Color fundus image. Captured on a Remidio FOP fundus camera: 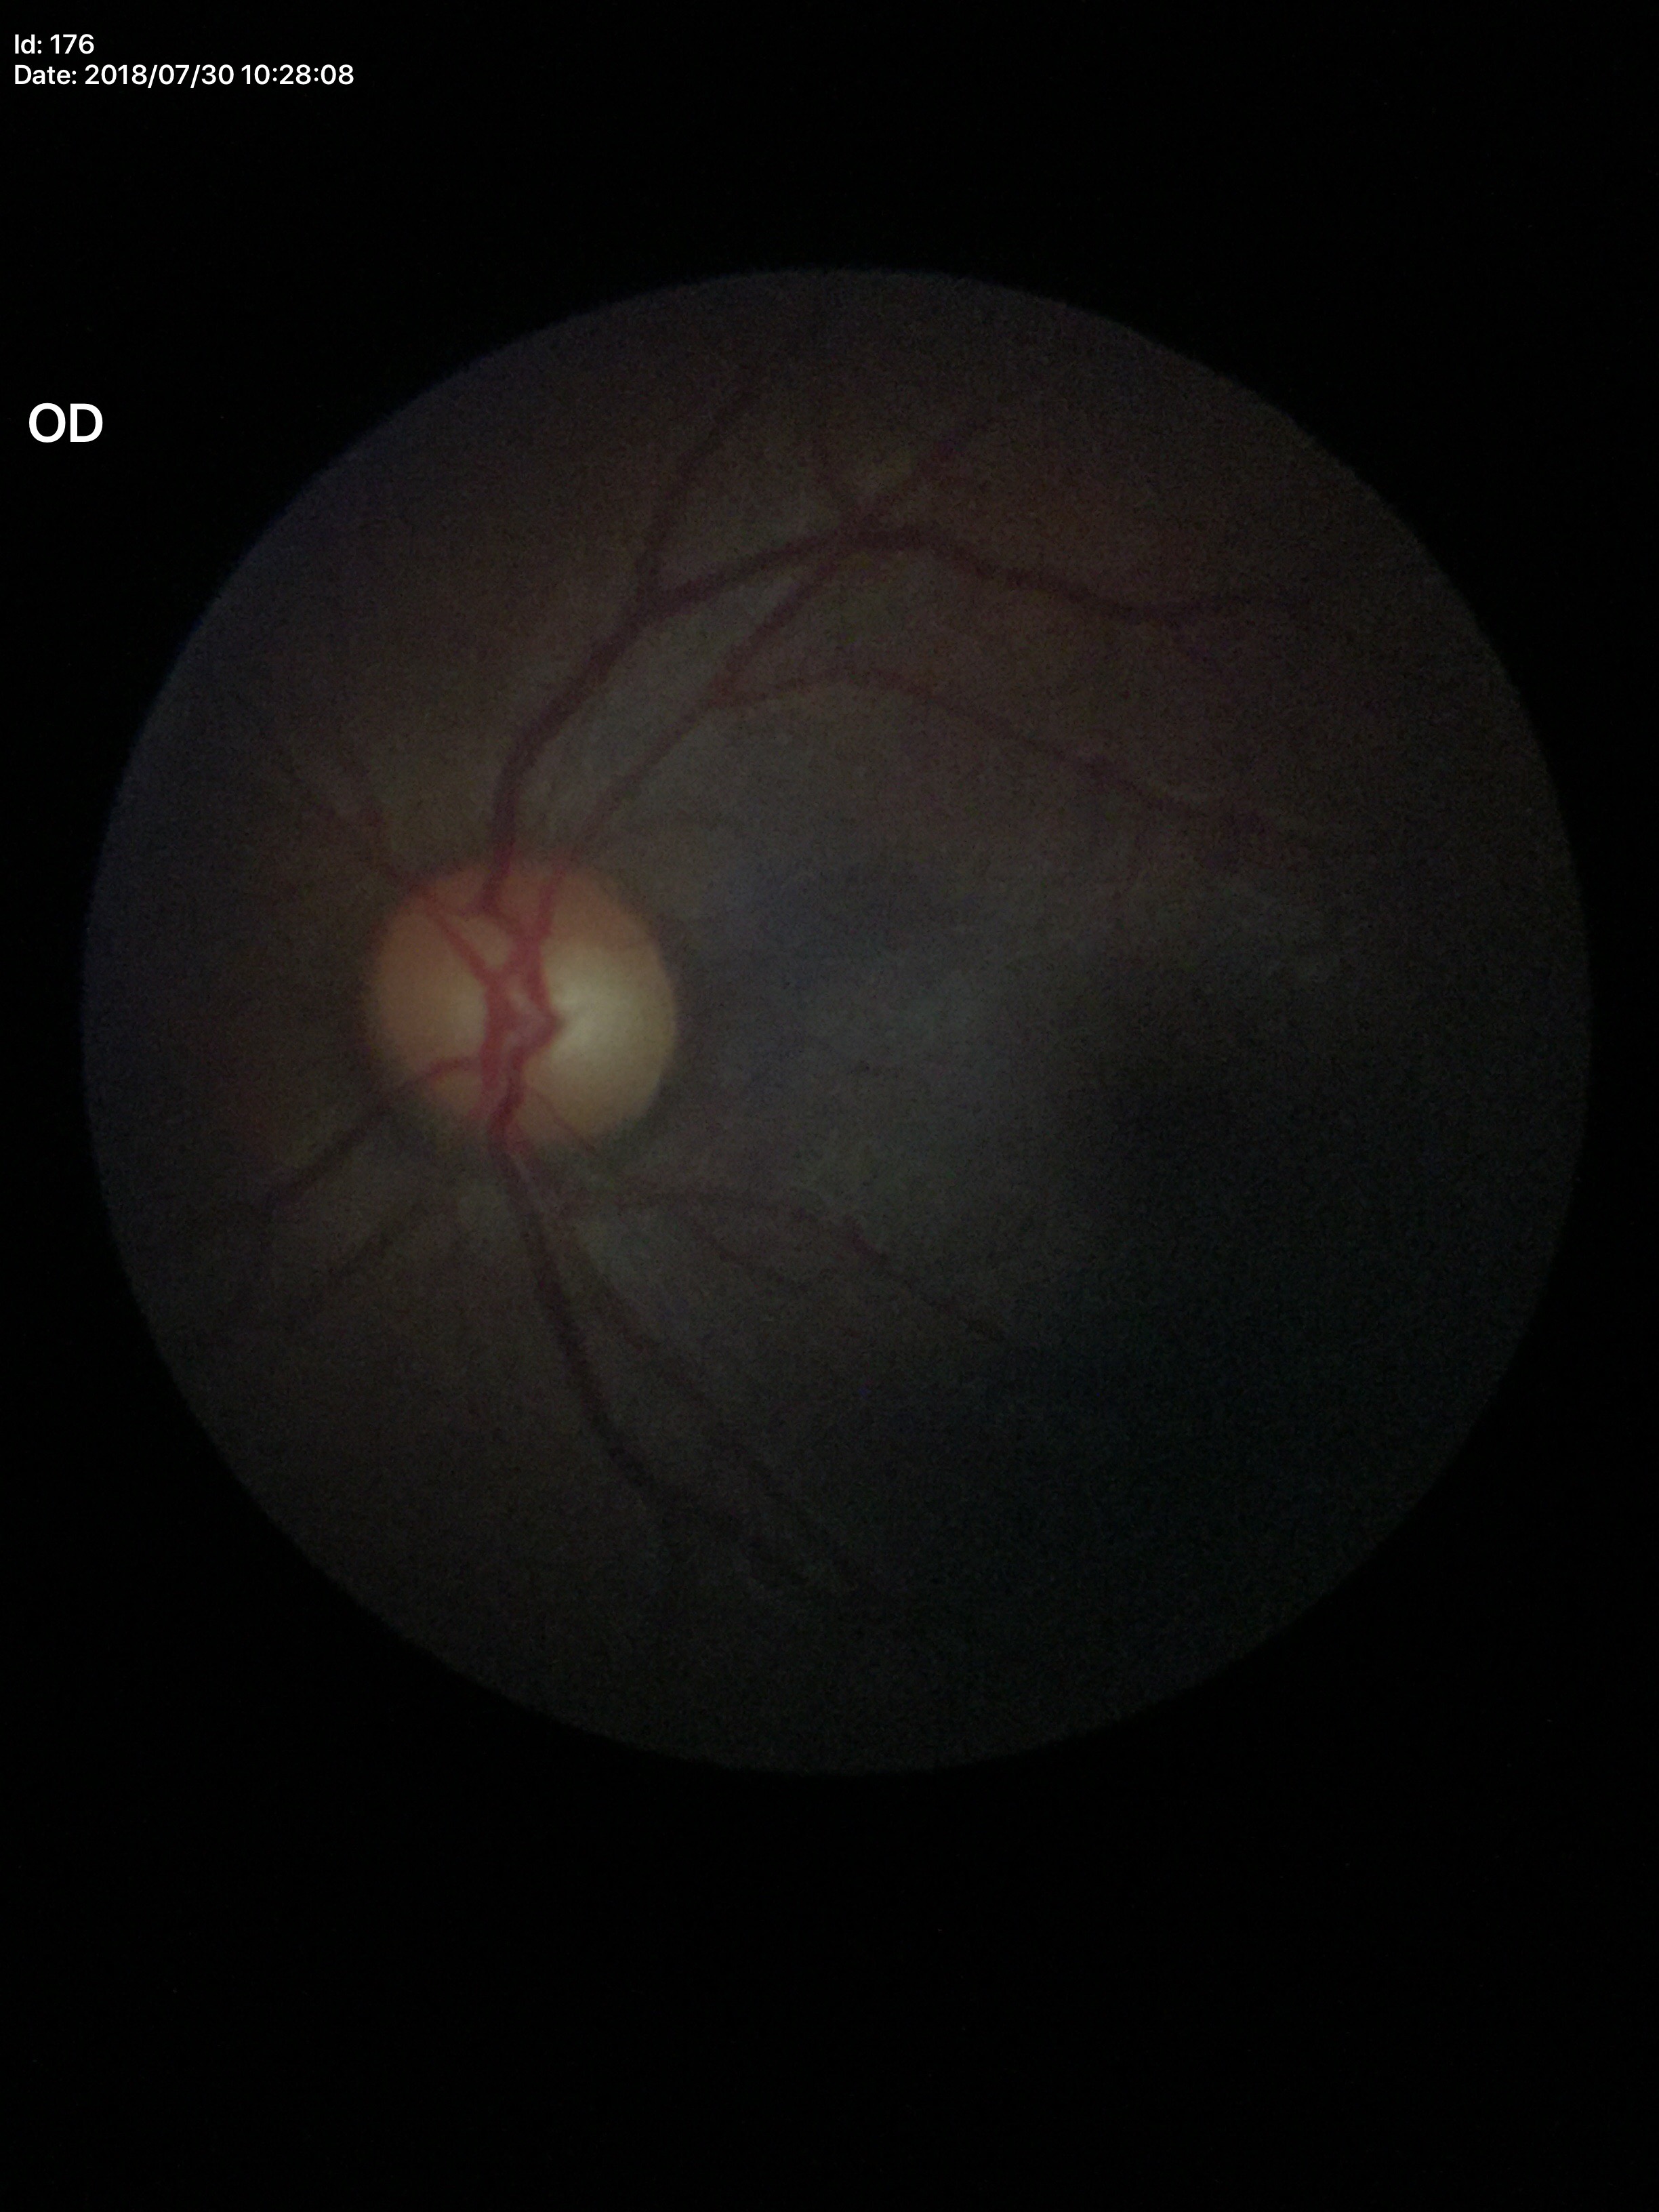

Vertical C/D ratio of 0.54.
No glaucomatous optic neuropathy (1/5 graders called glaucoma suspect).
Horizontal C/D ratio is 0.56.